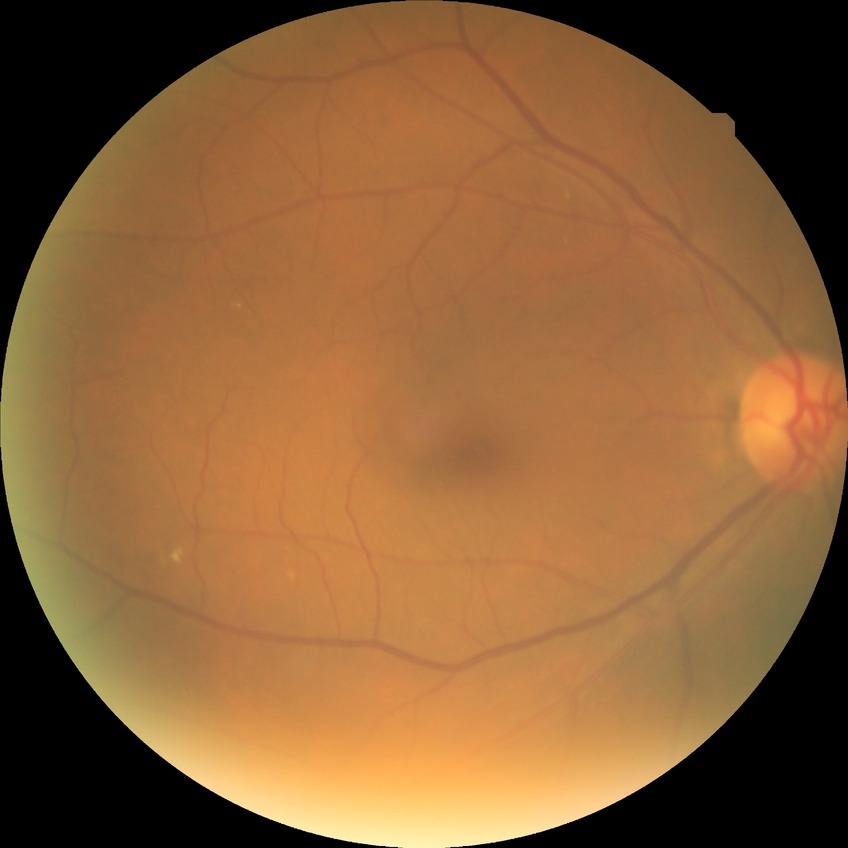
Diabetic retinopathy (DR) is no diabetic retinopathy (NDR).